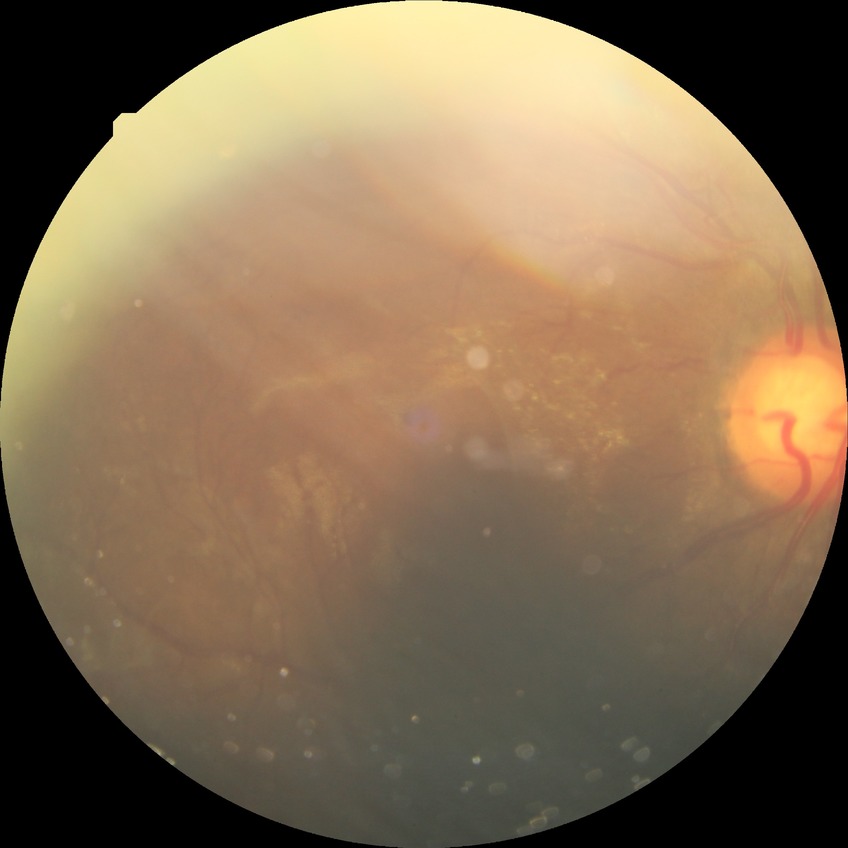

Retinopathy stage is proliferative diabetic retinopathy.